Wide-field fundus photograph from neonatal ROP screening.
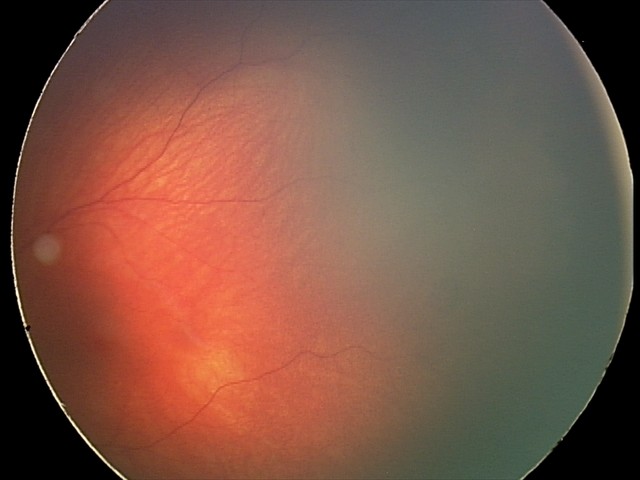 From an examination with diagnosis of retinal hemorrhages.